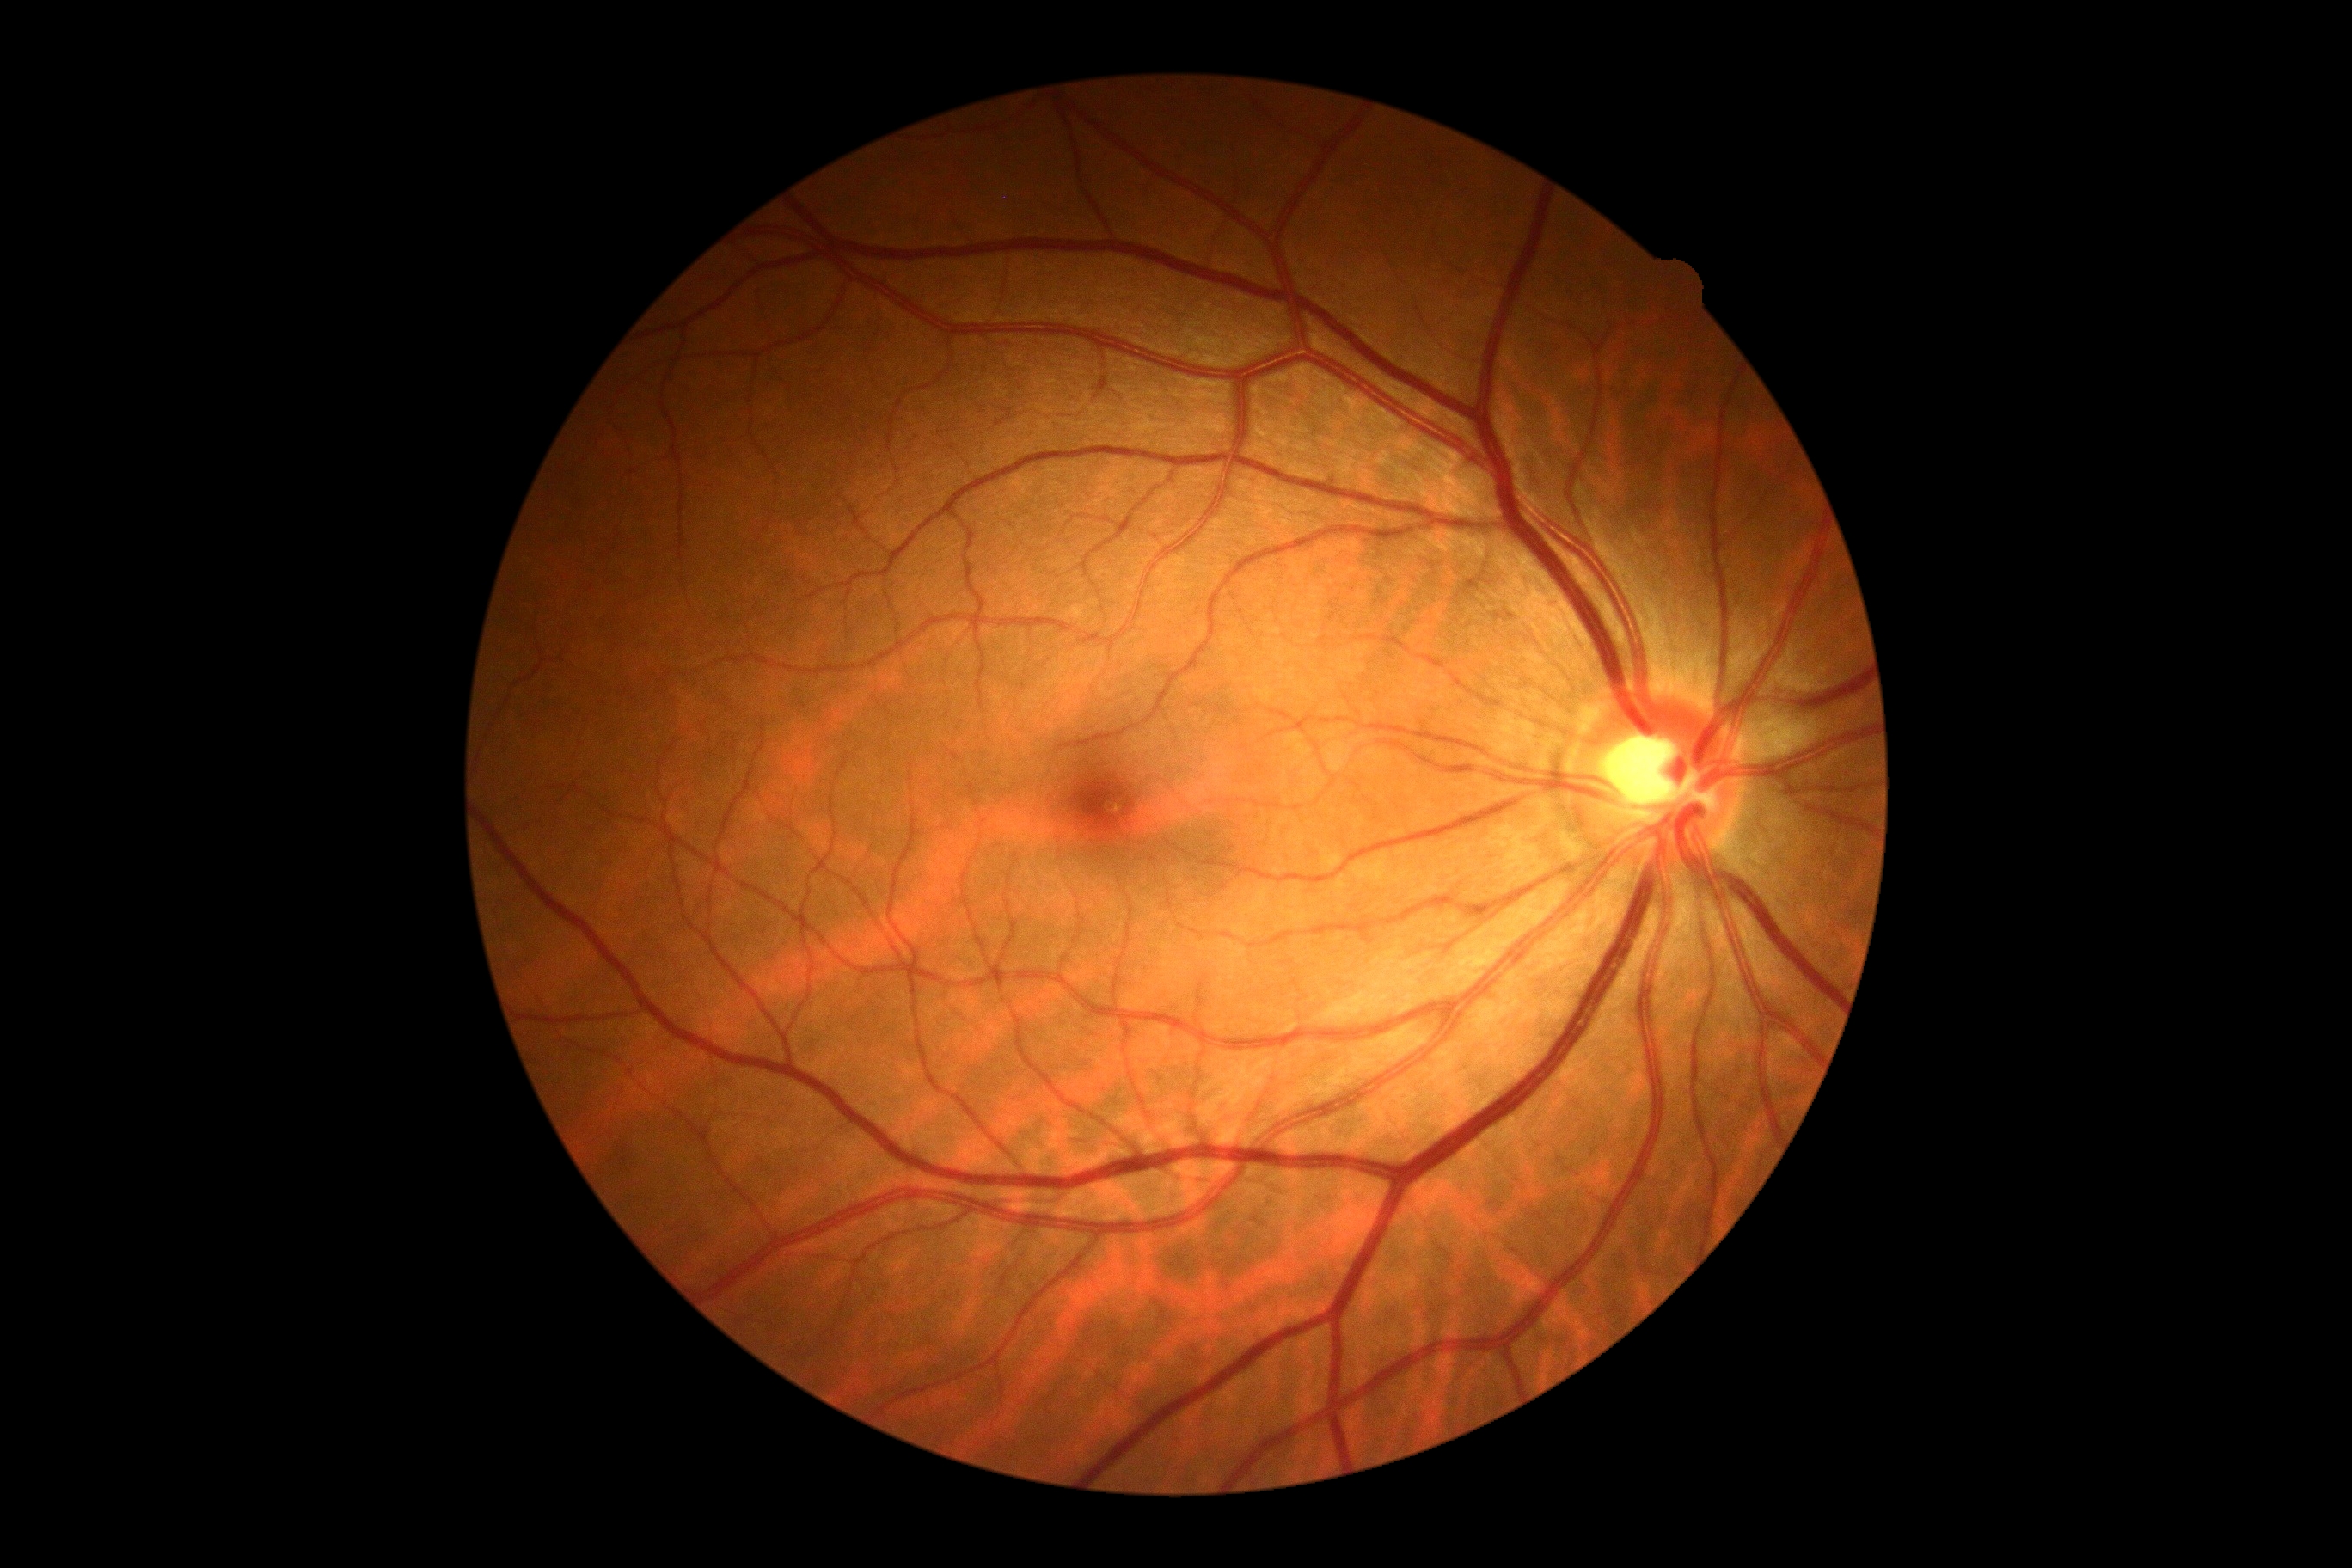
Diabetic retinopathy (DR) is 0.